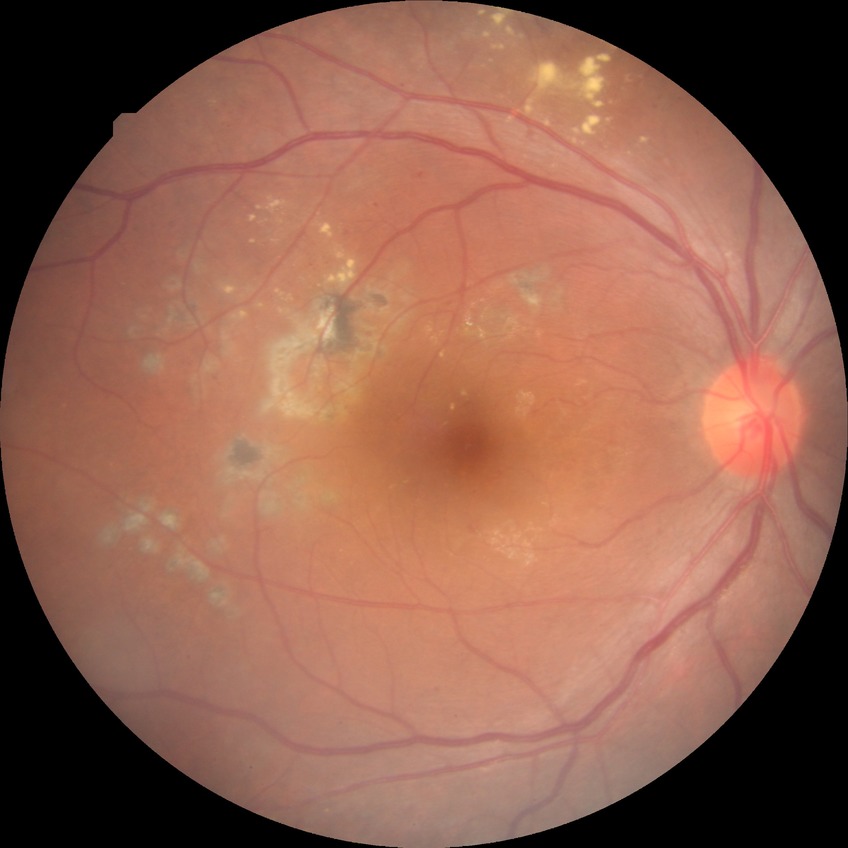

{"davis_grade": "proliferative diabetic retinopathy"}